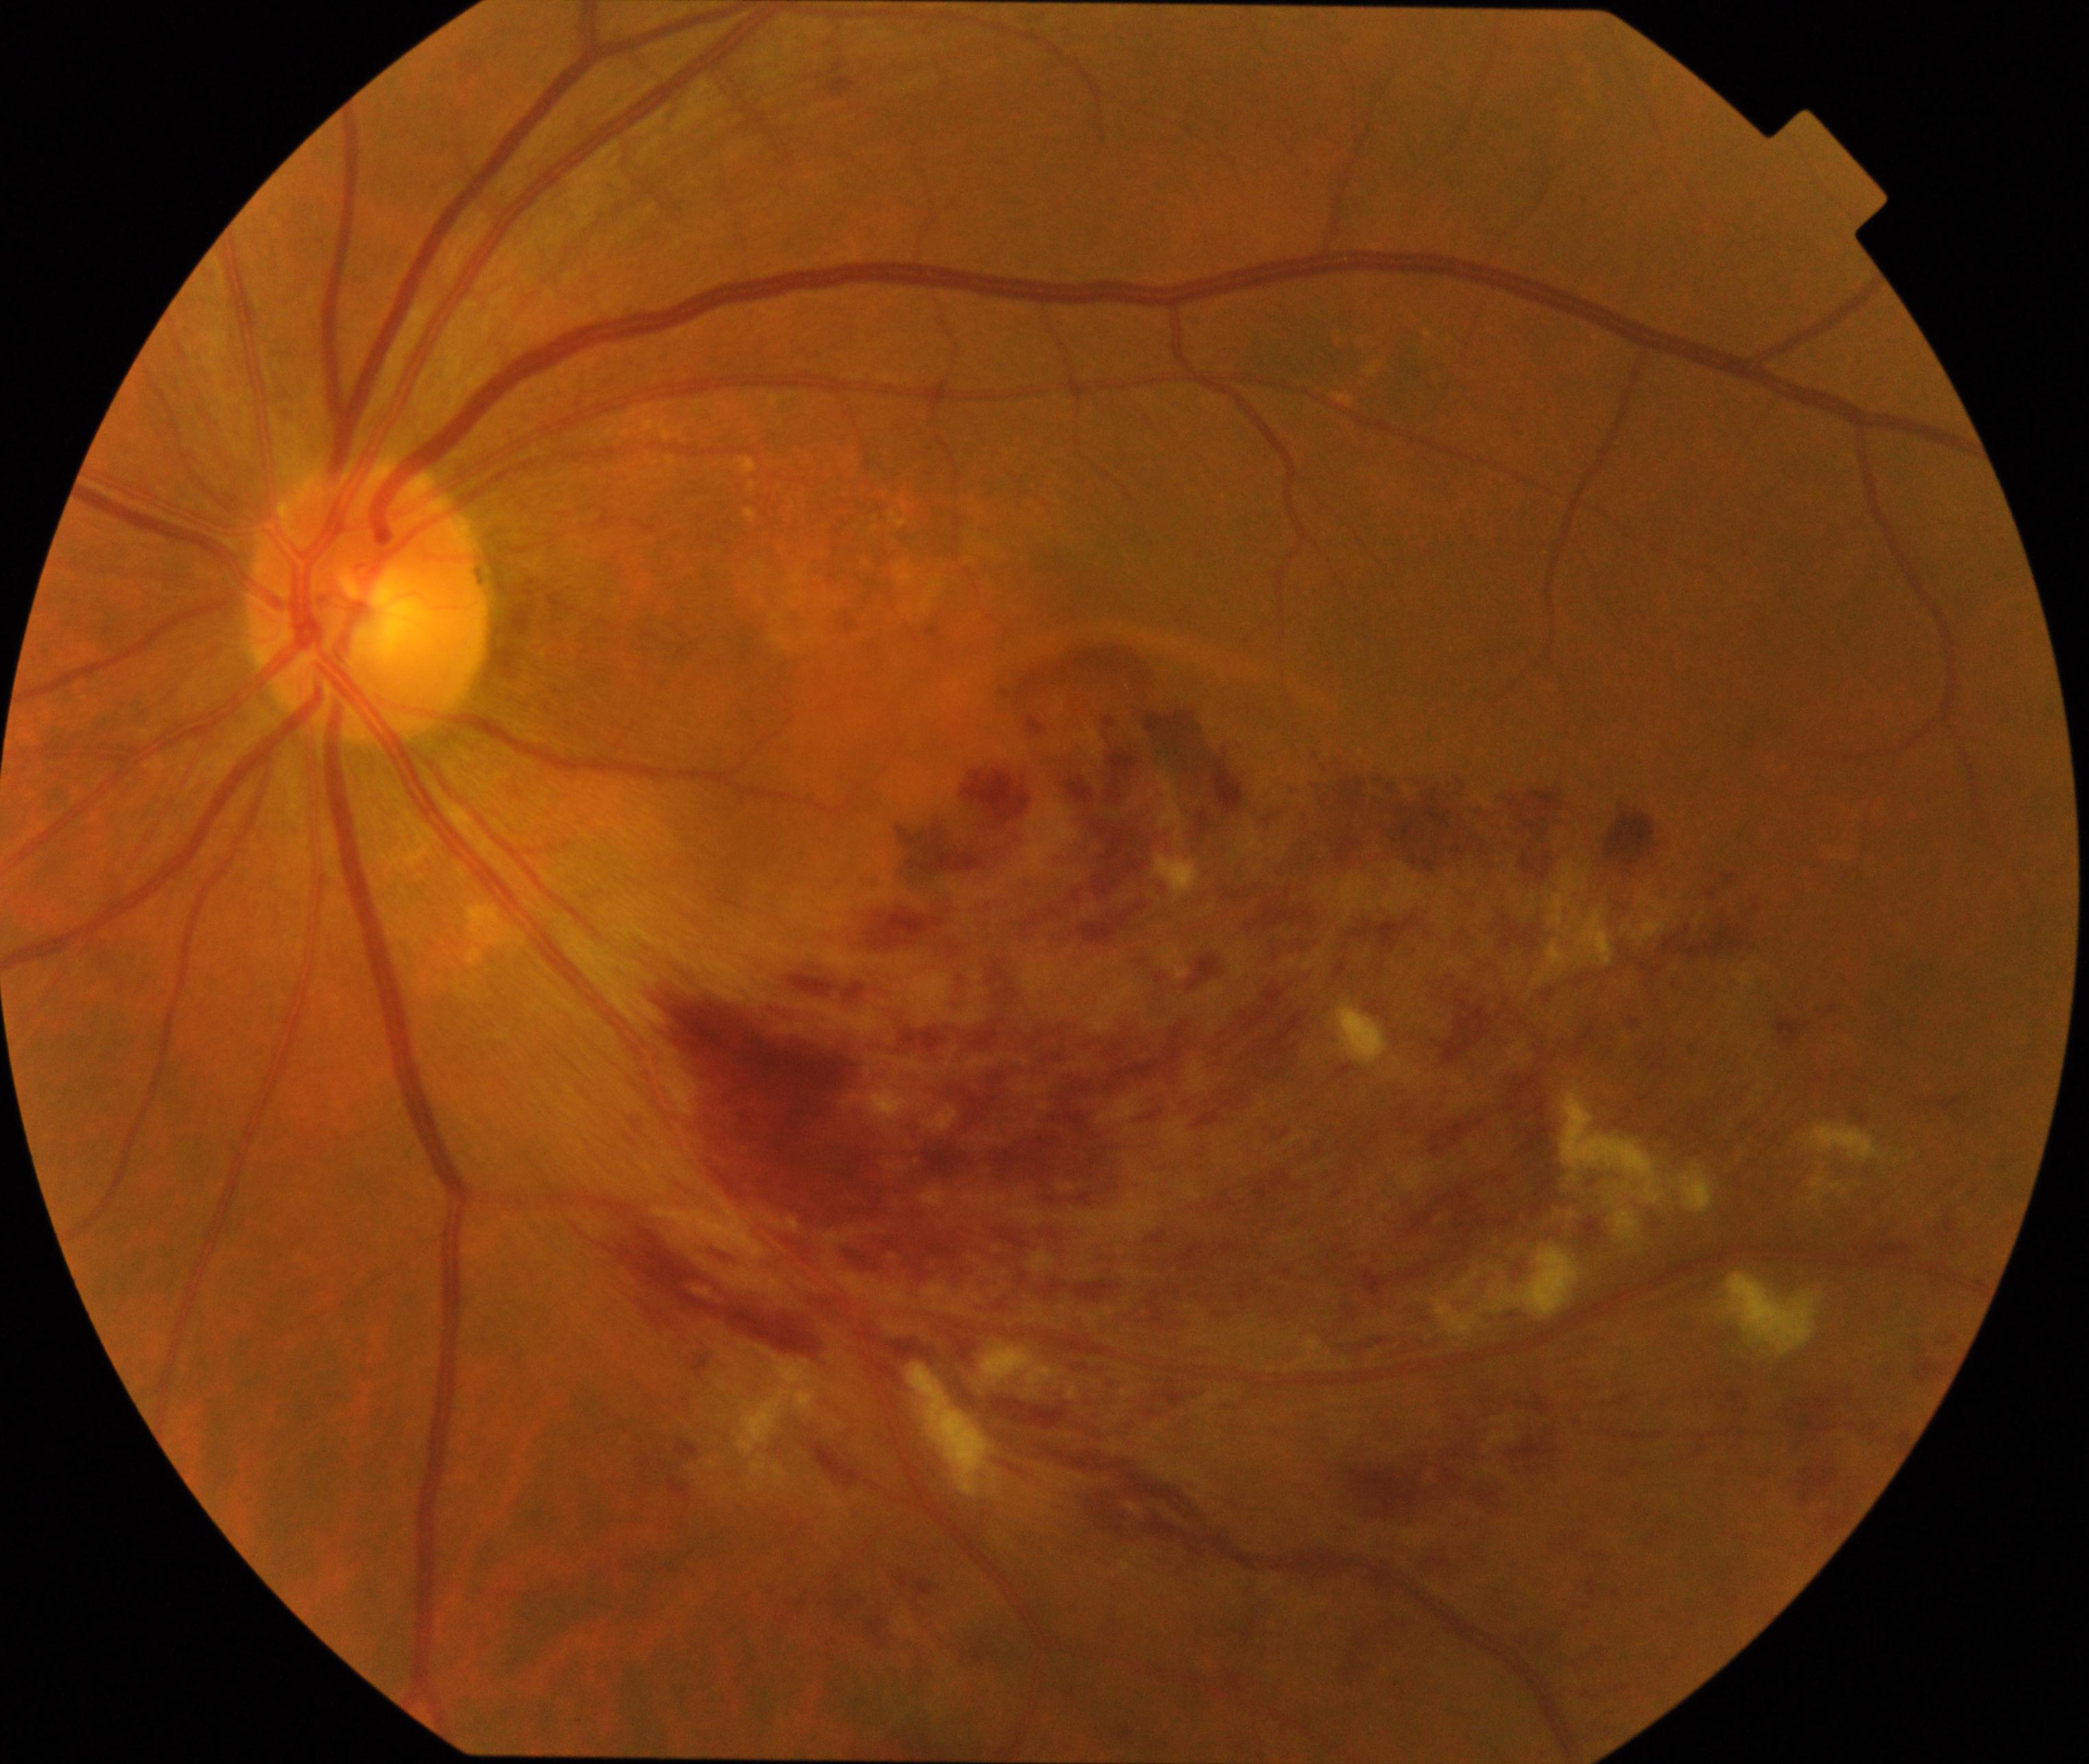
Consistent with branch retinal vein occlusion.